Color fundus image. Image size 848x848. Acquired with a NIDEK AFC-230. 45 degree fundus photograph.
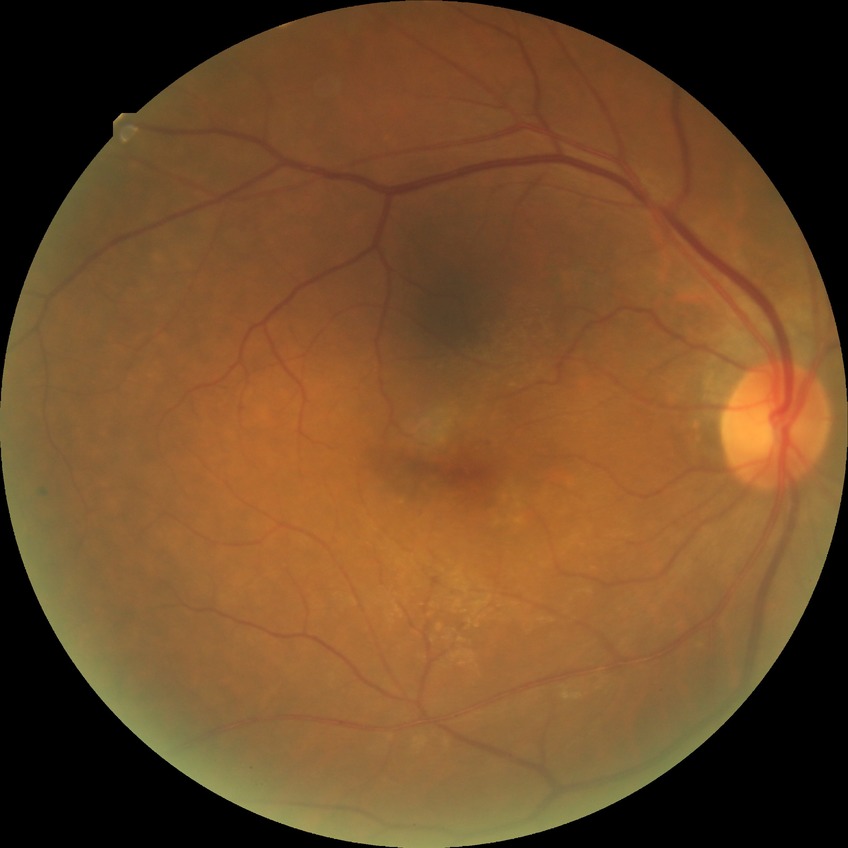
No apparent diabetic retinopathy. Davis stage is NDR.